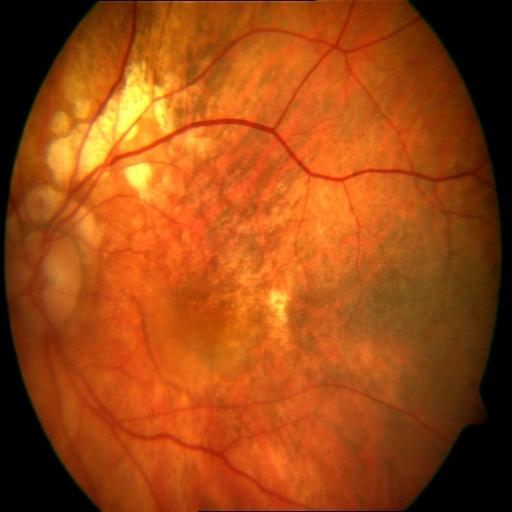 Impression:
- myopia